FOV: 45 degrees, fundus photo: 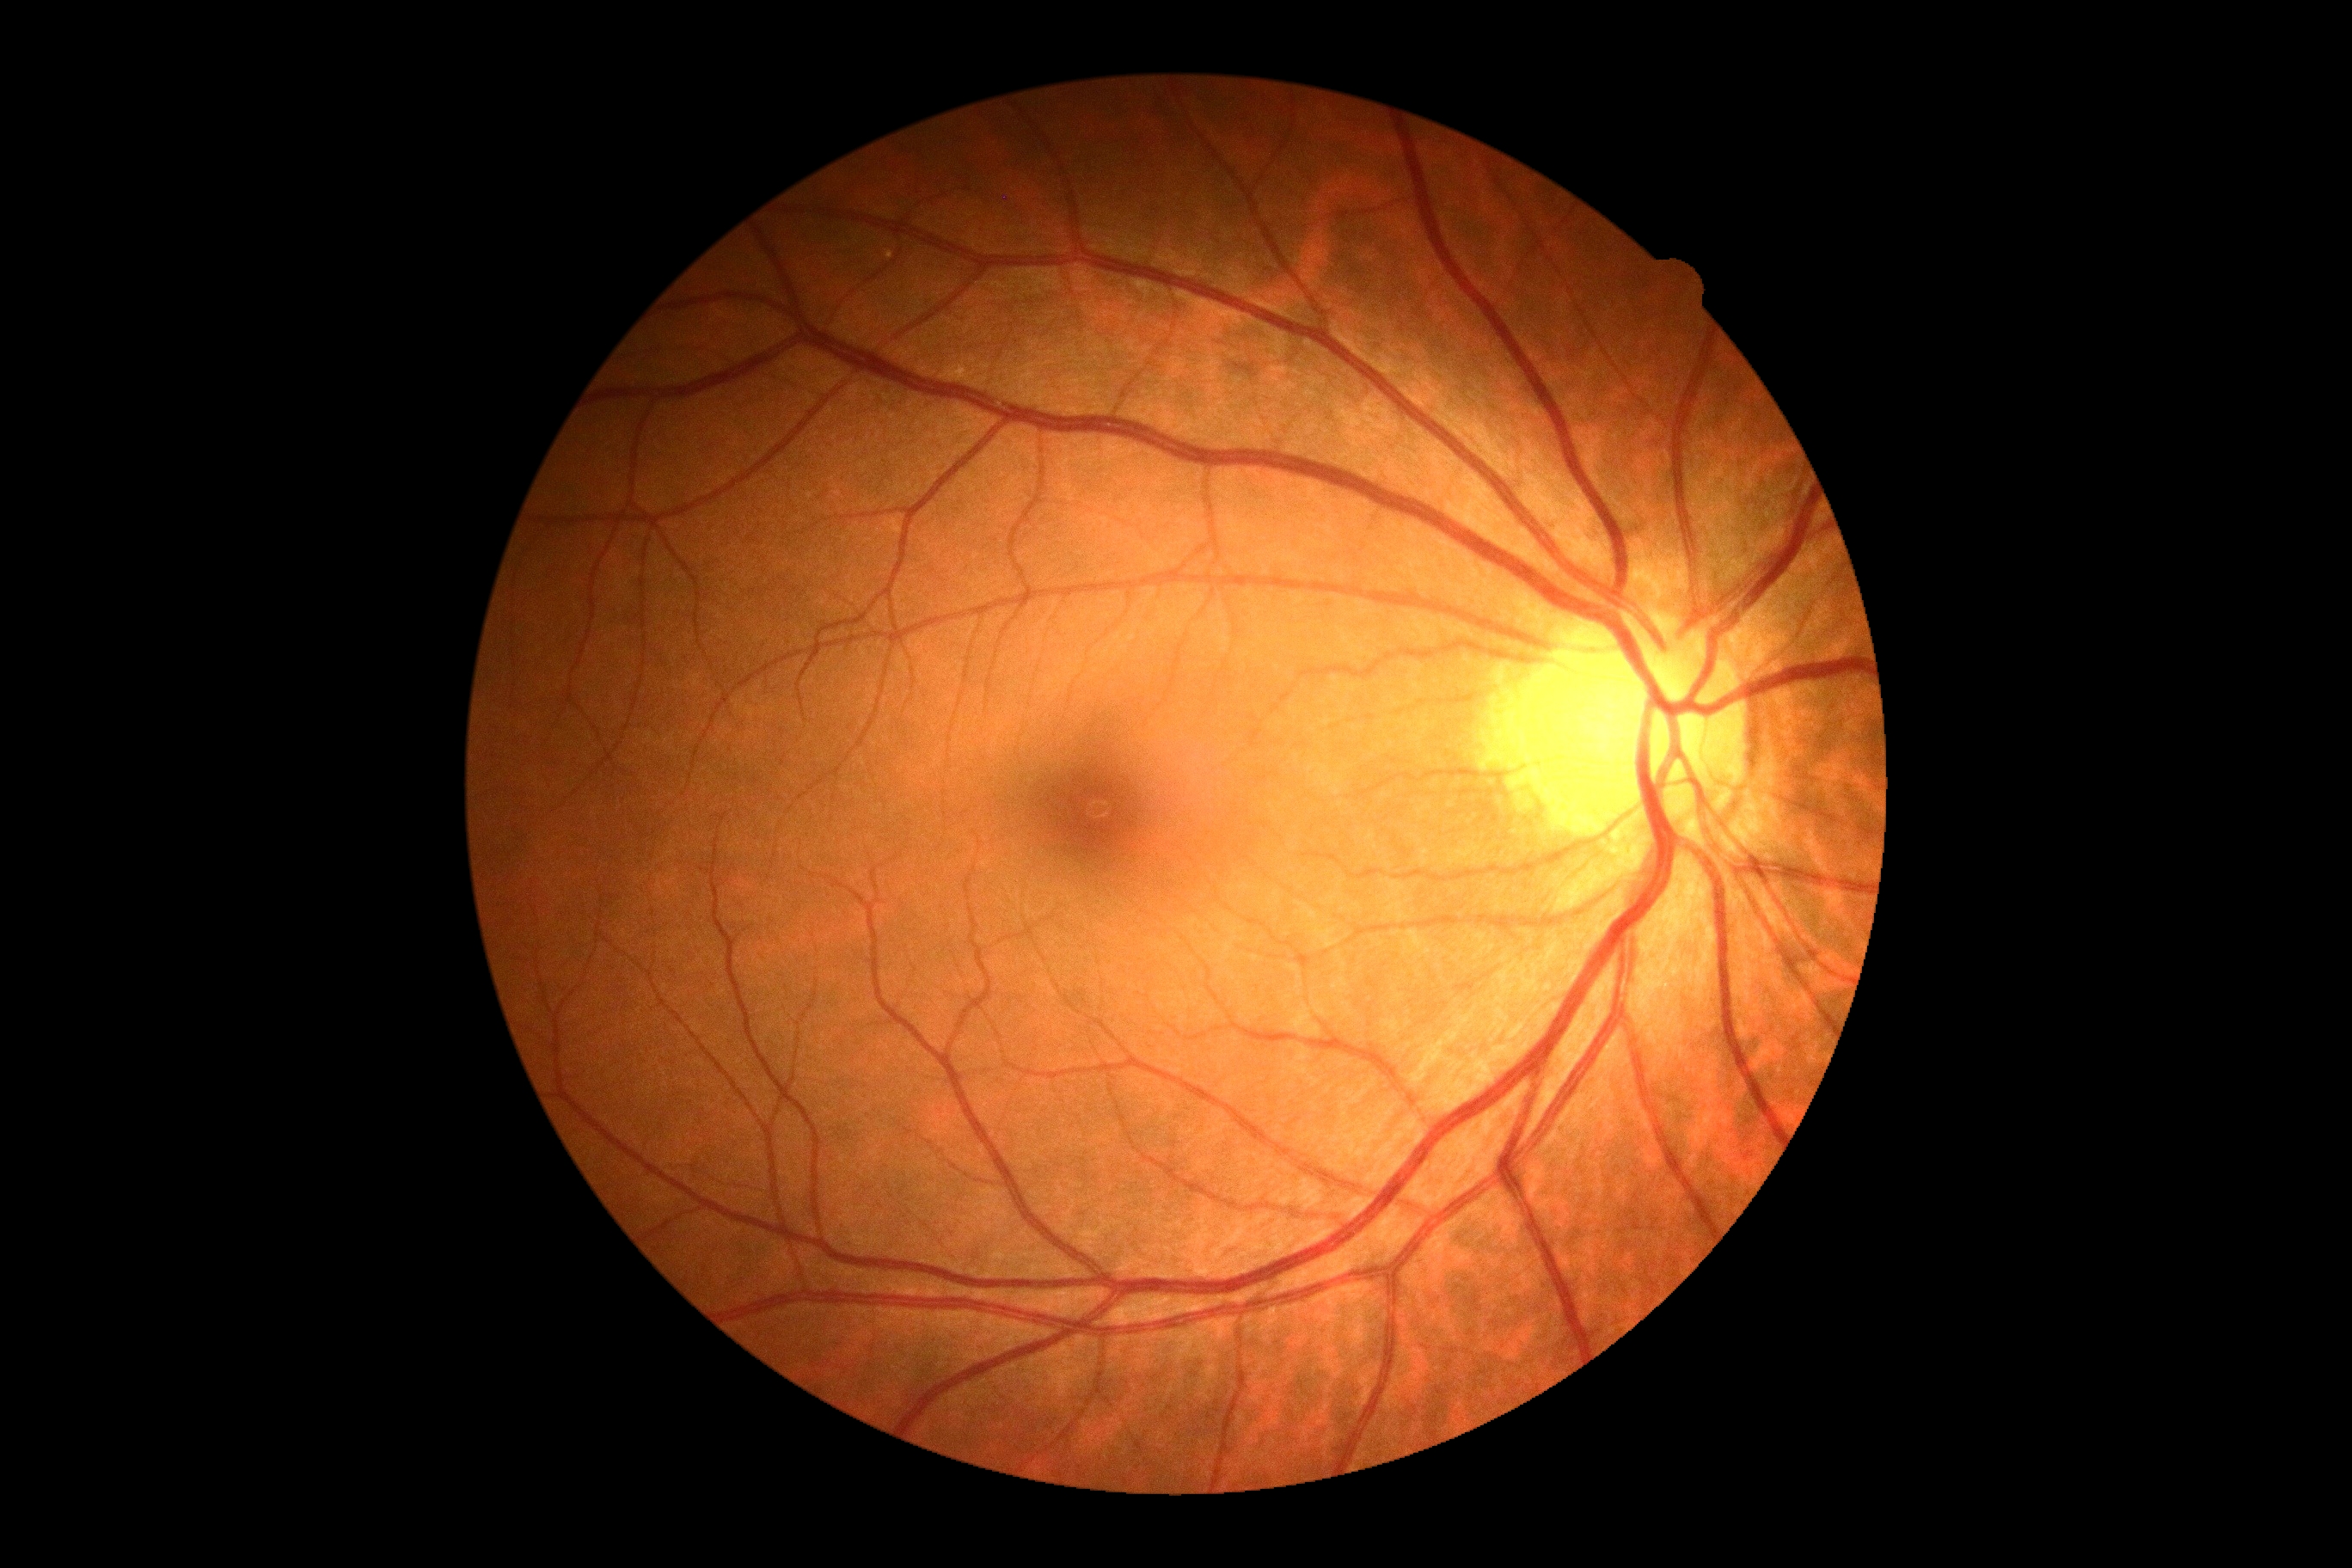
Findings:
- DR grade: 0 (no apparent retinopathy)